200° field of view. Ultra-widefield fundus photograph. 1924x1556px: 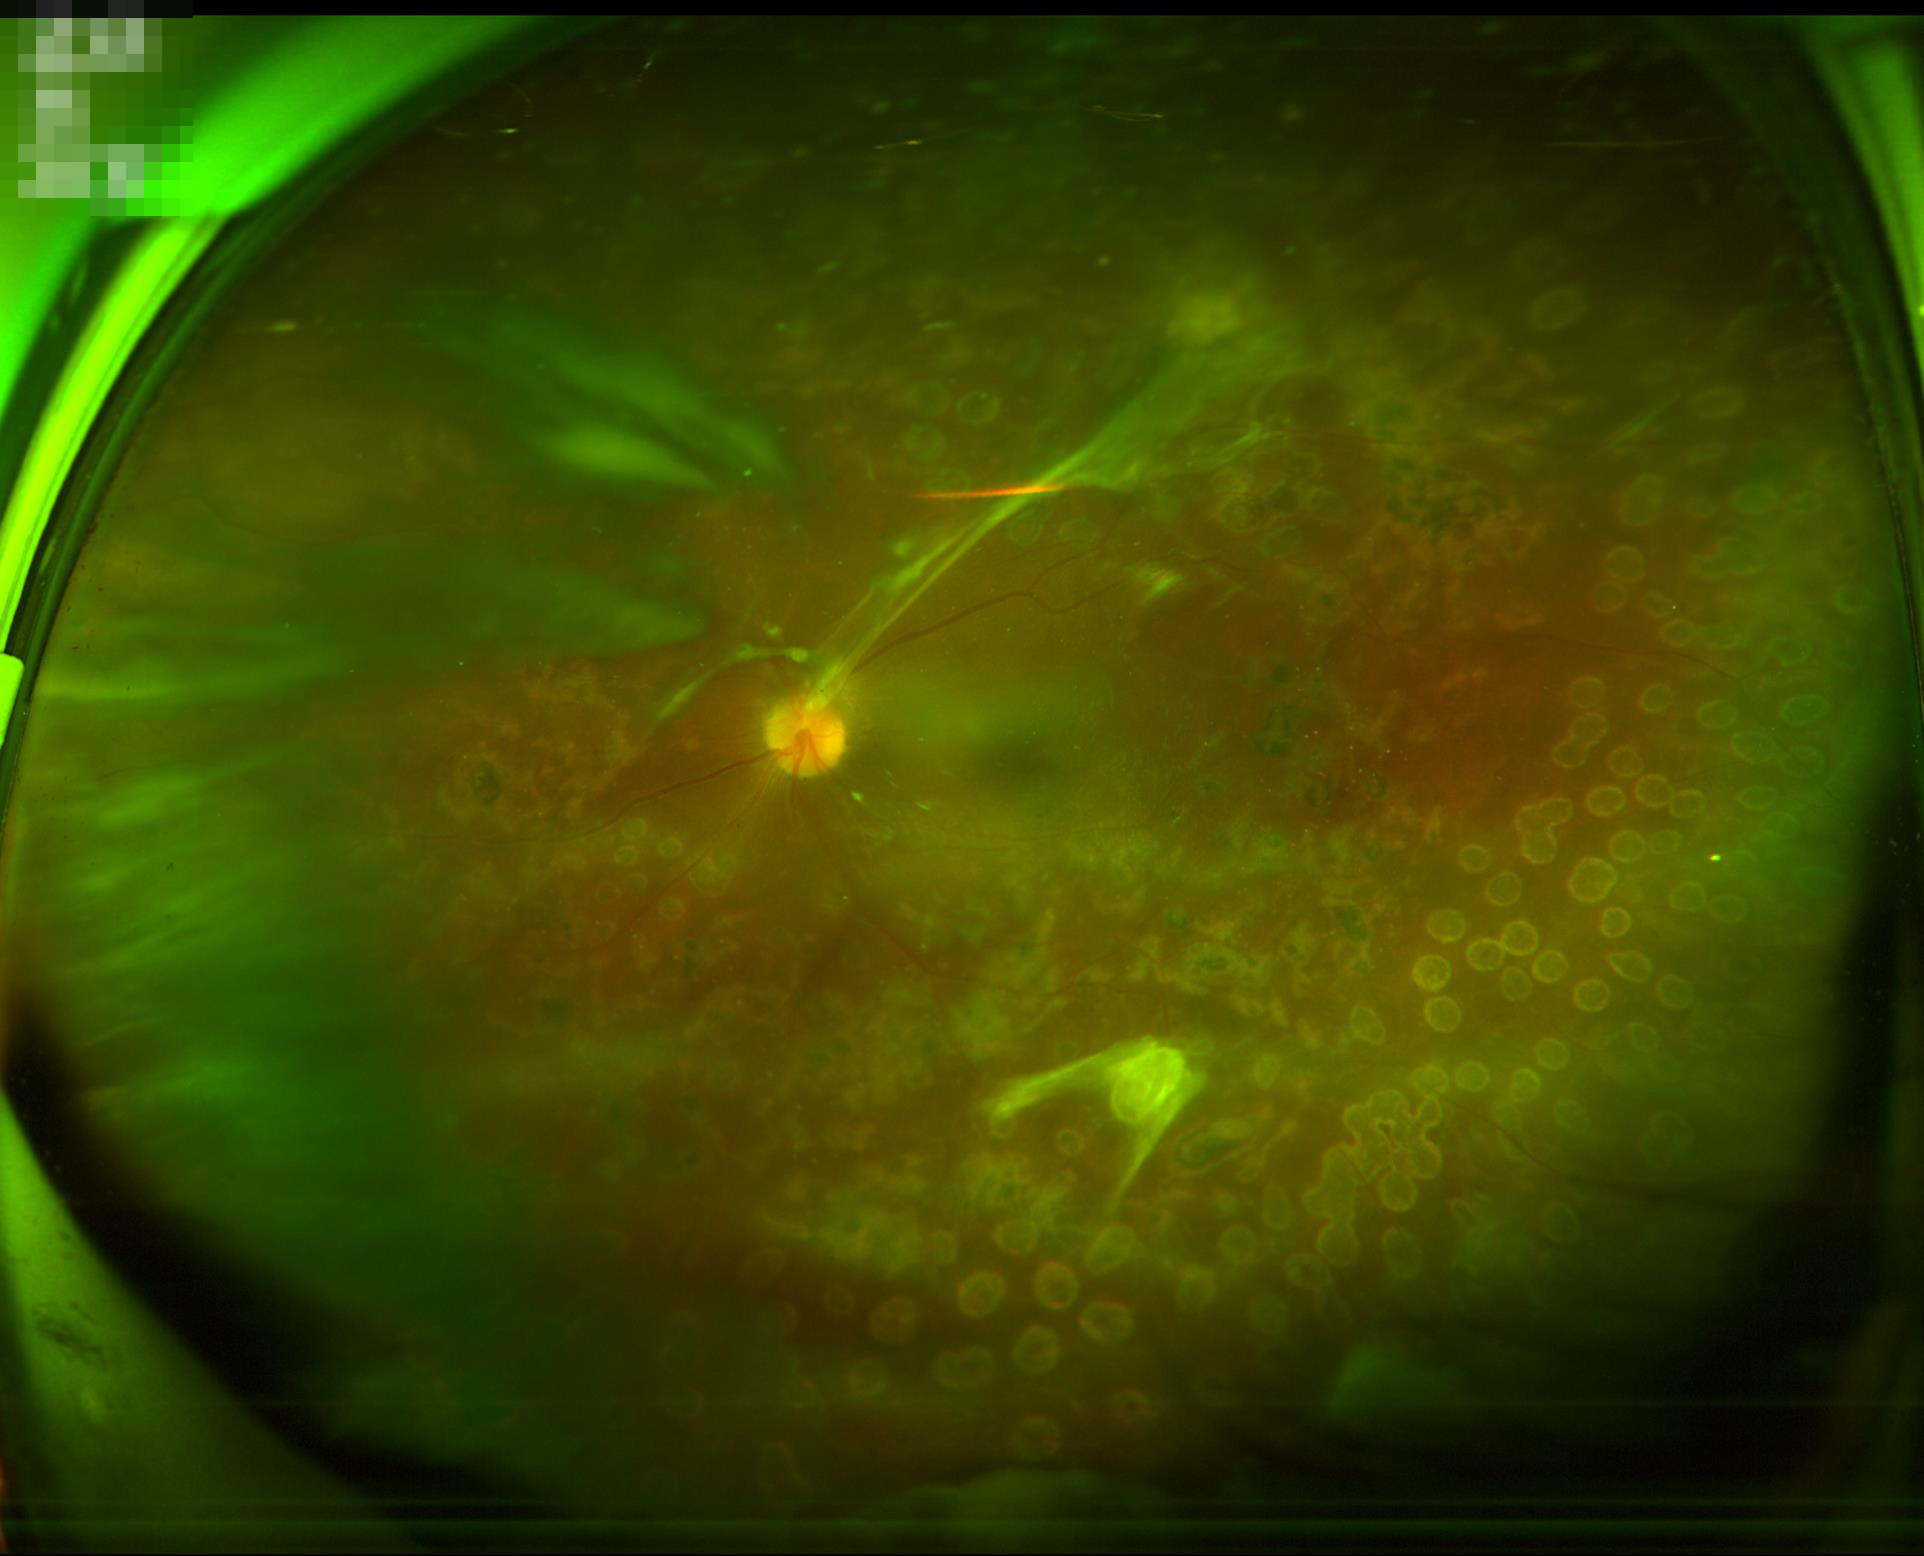

  overall_quality: low
  clarity: blurry
  contrast: satisfactory
  illumination: poor